Fundus photo. 2352 x 1568 pixels: 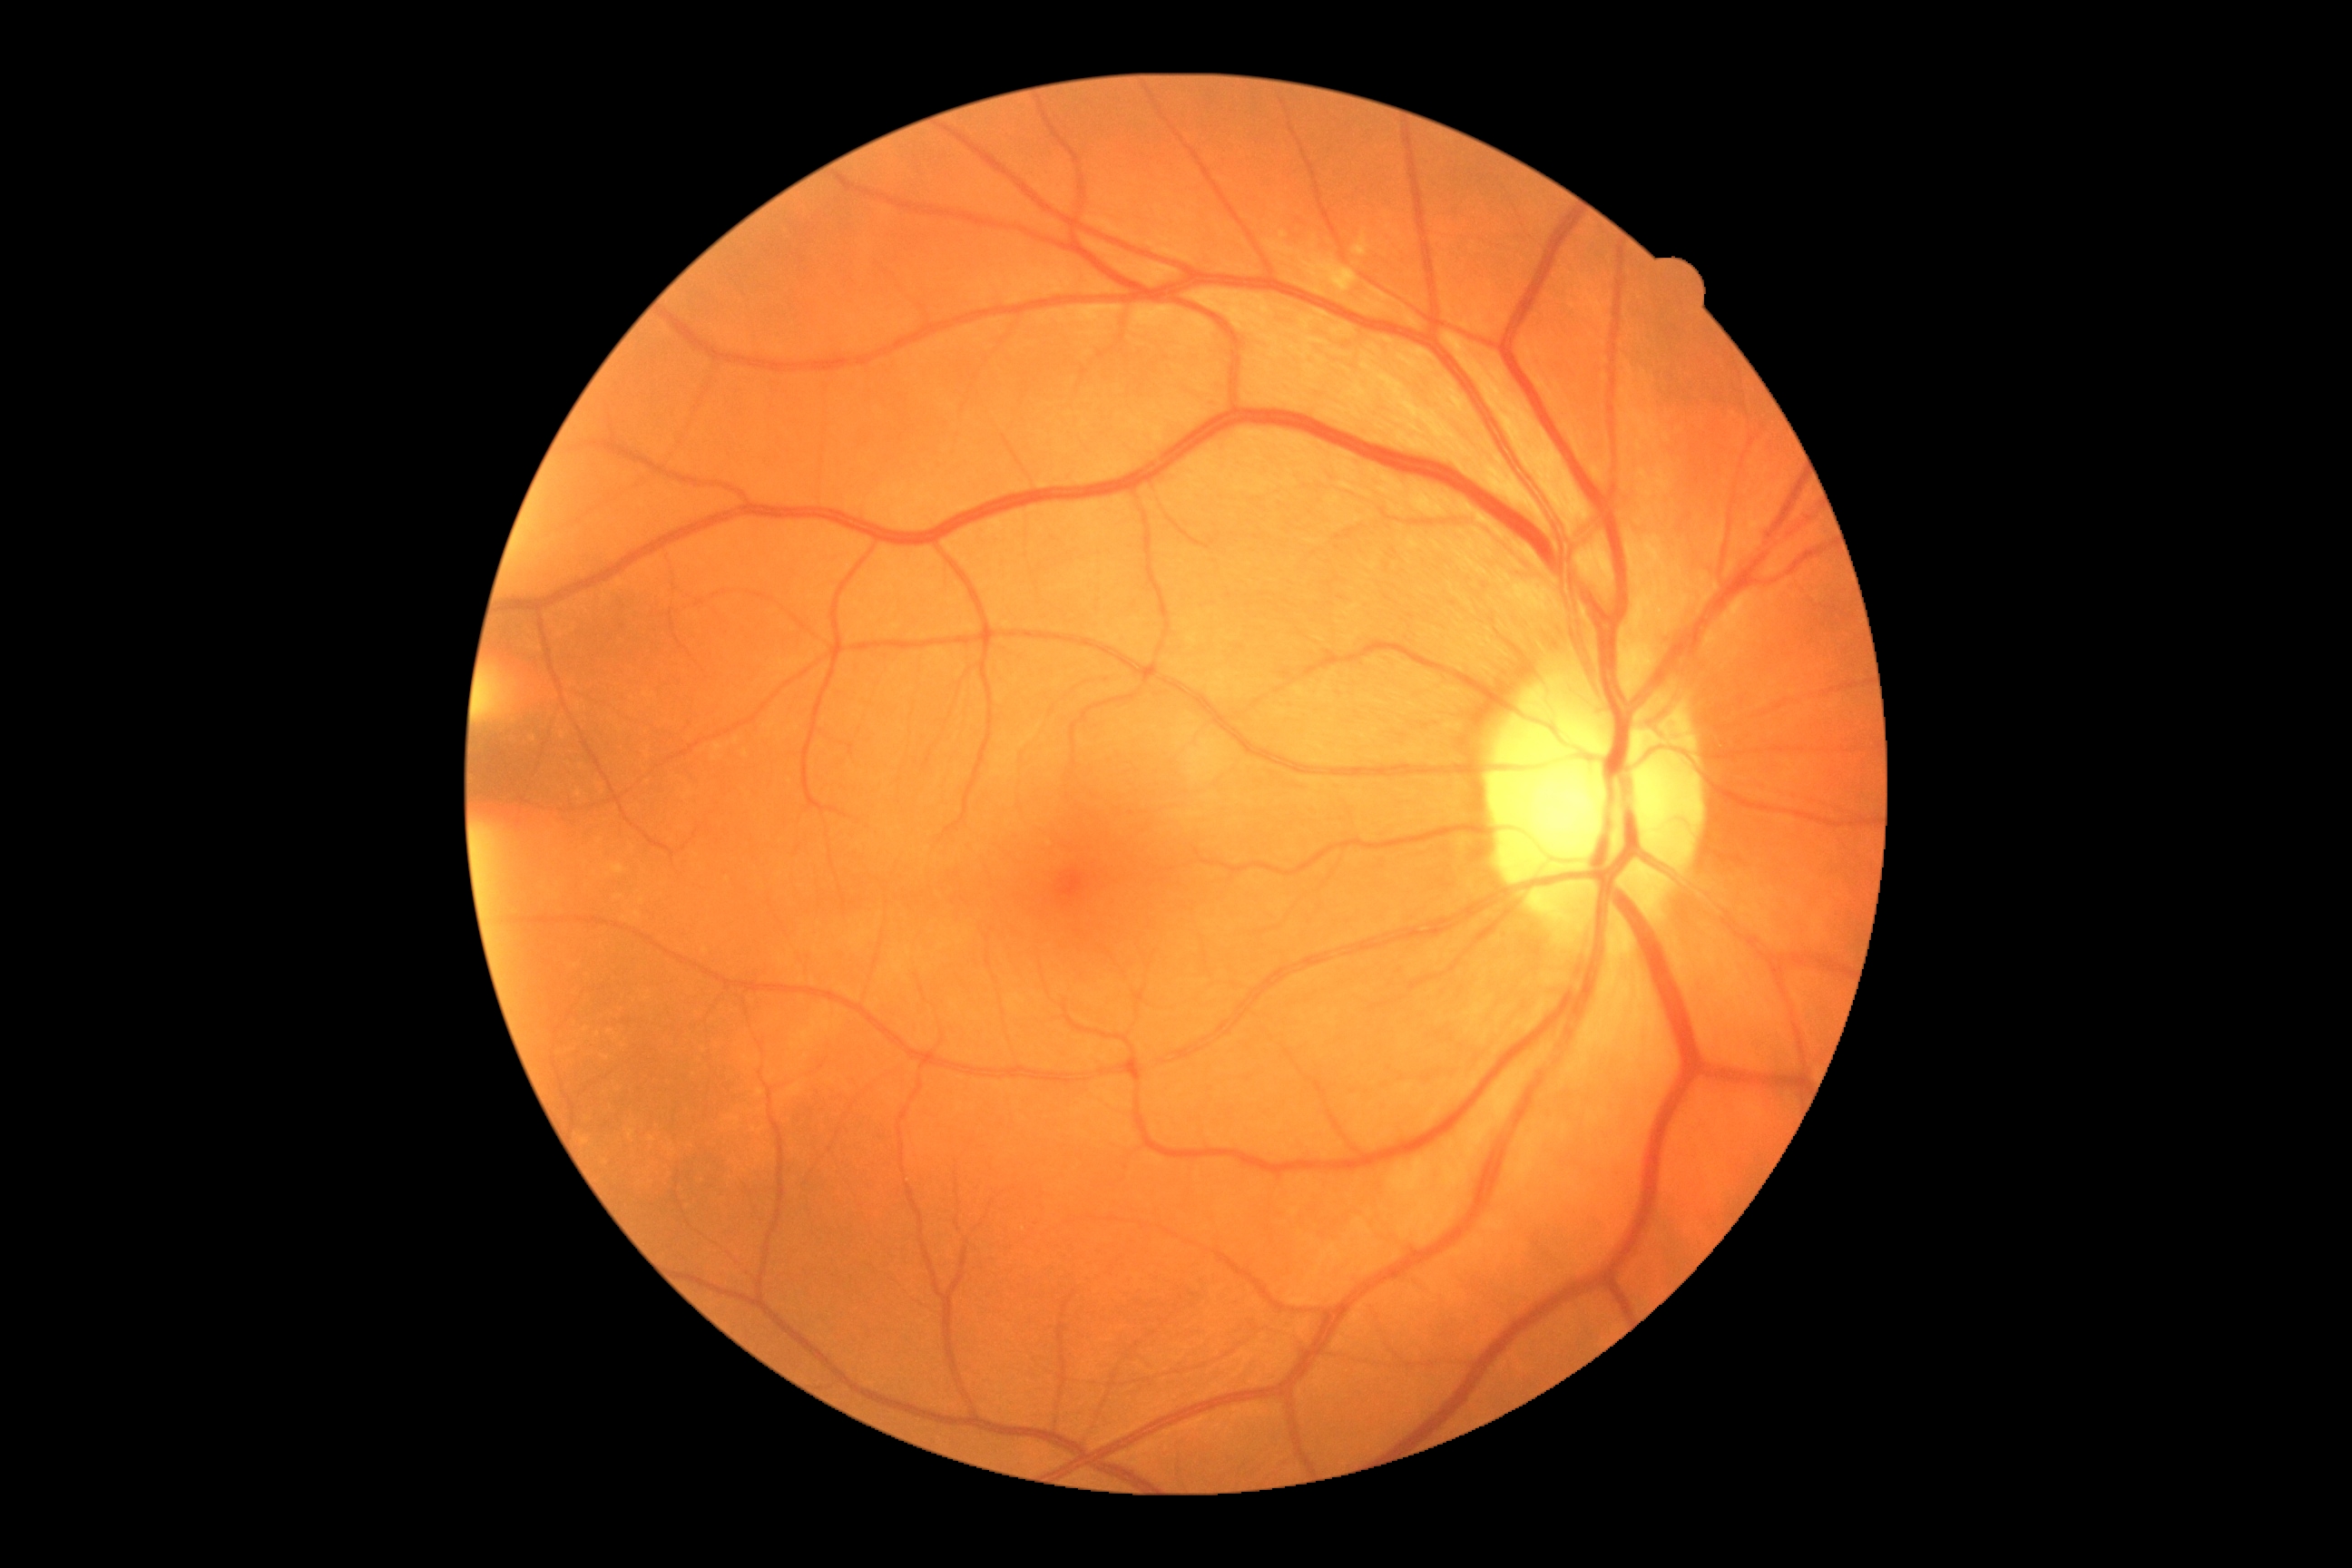
{"dr_grade": "no apparent retinopathy (grade 0)"}